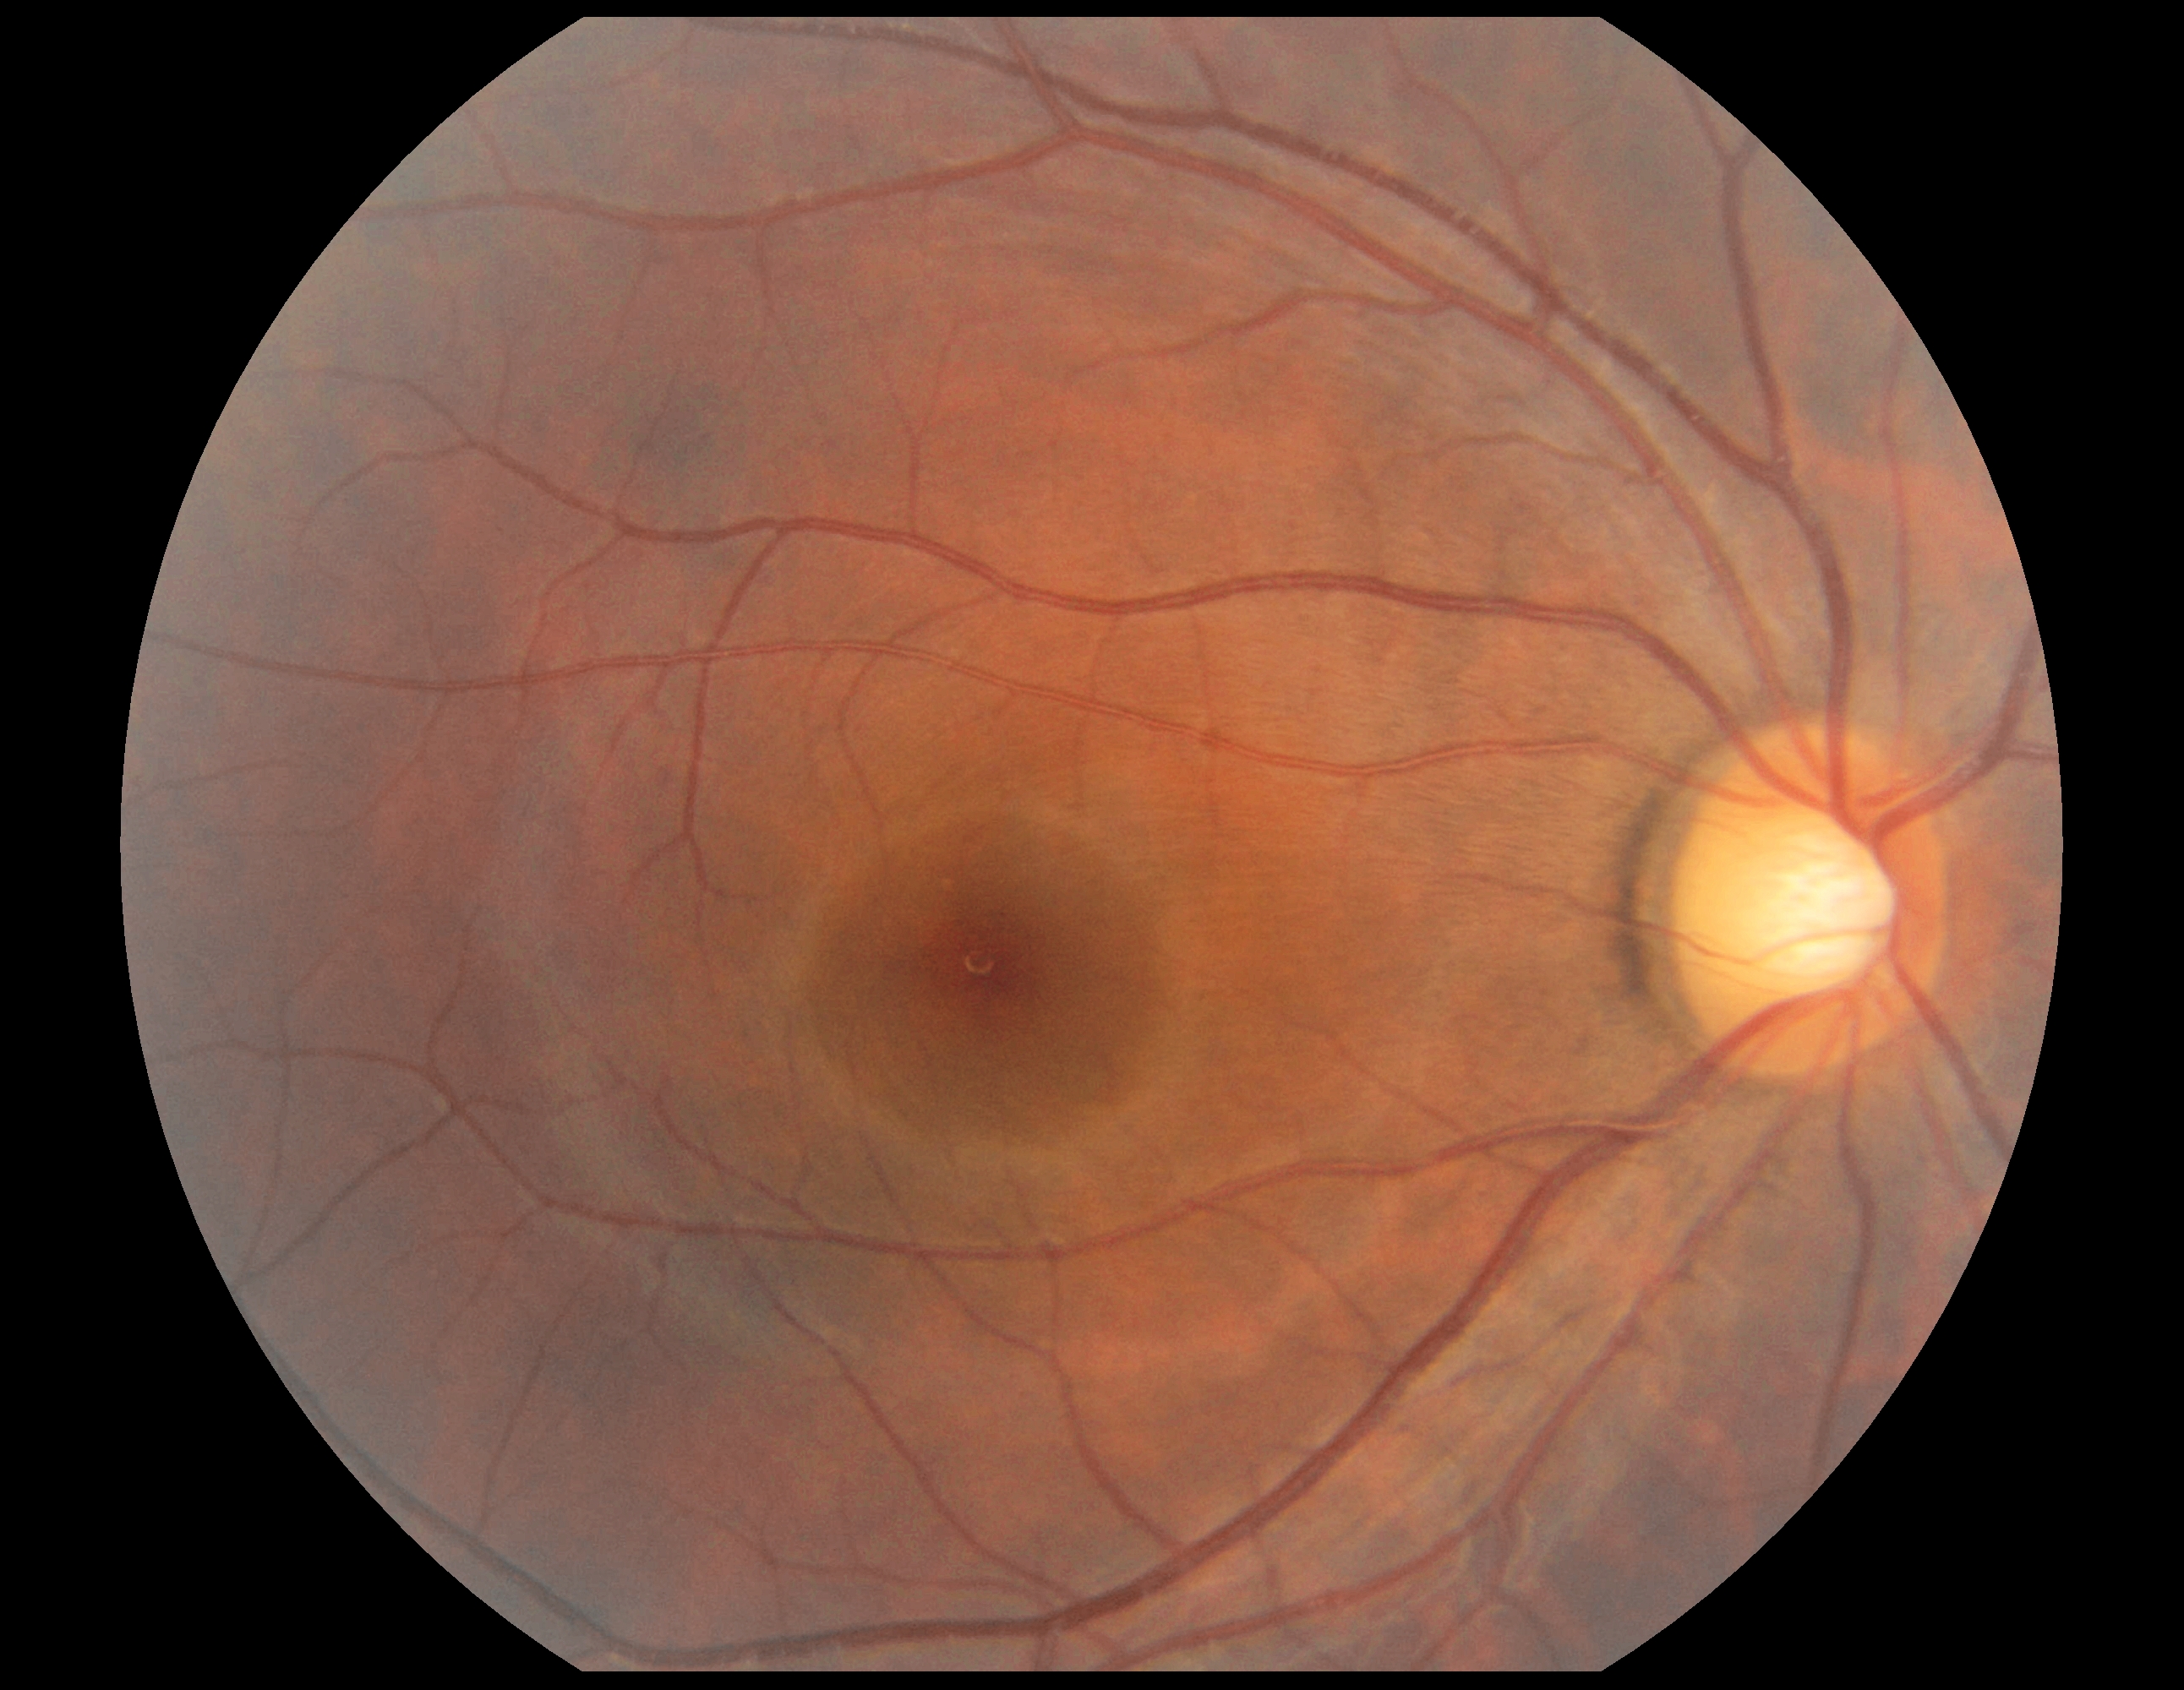
Diabetic retinopathy severity: grade 0 (no apparent retinopathy).